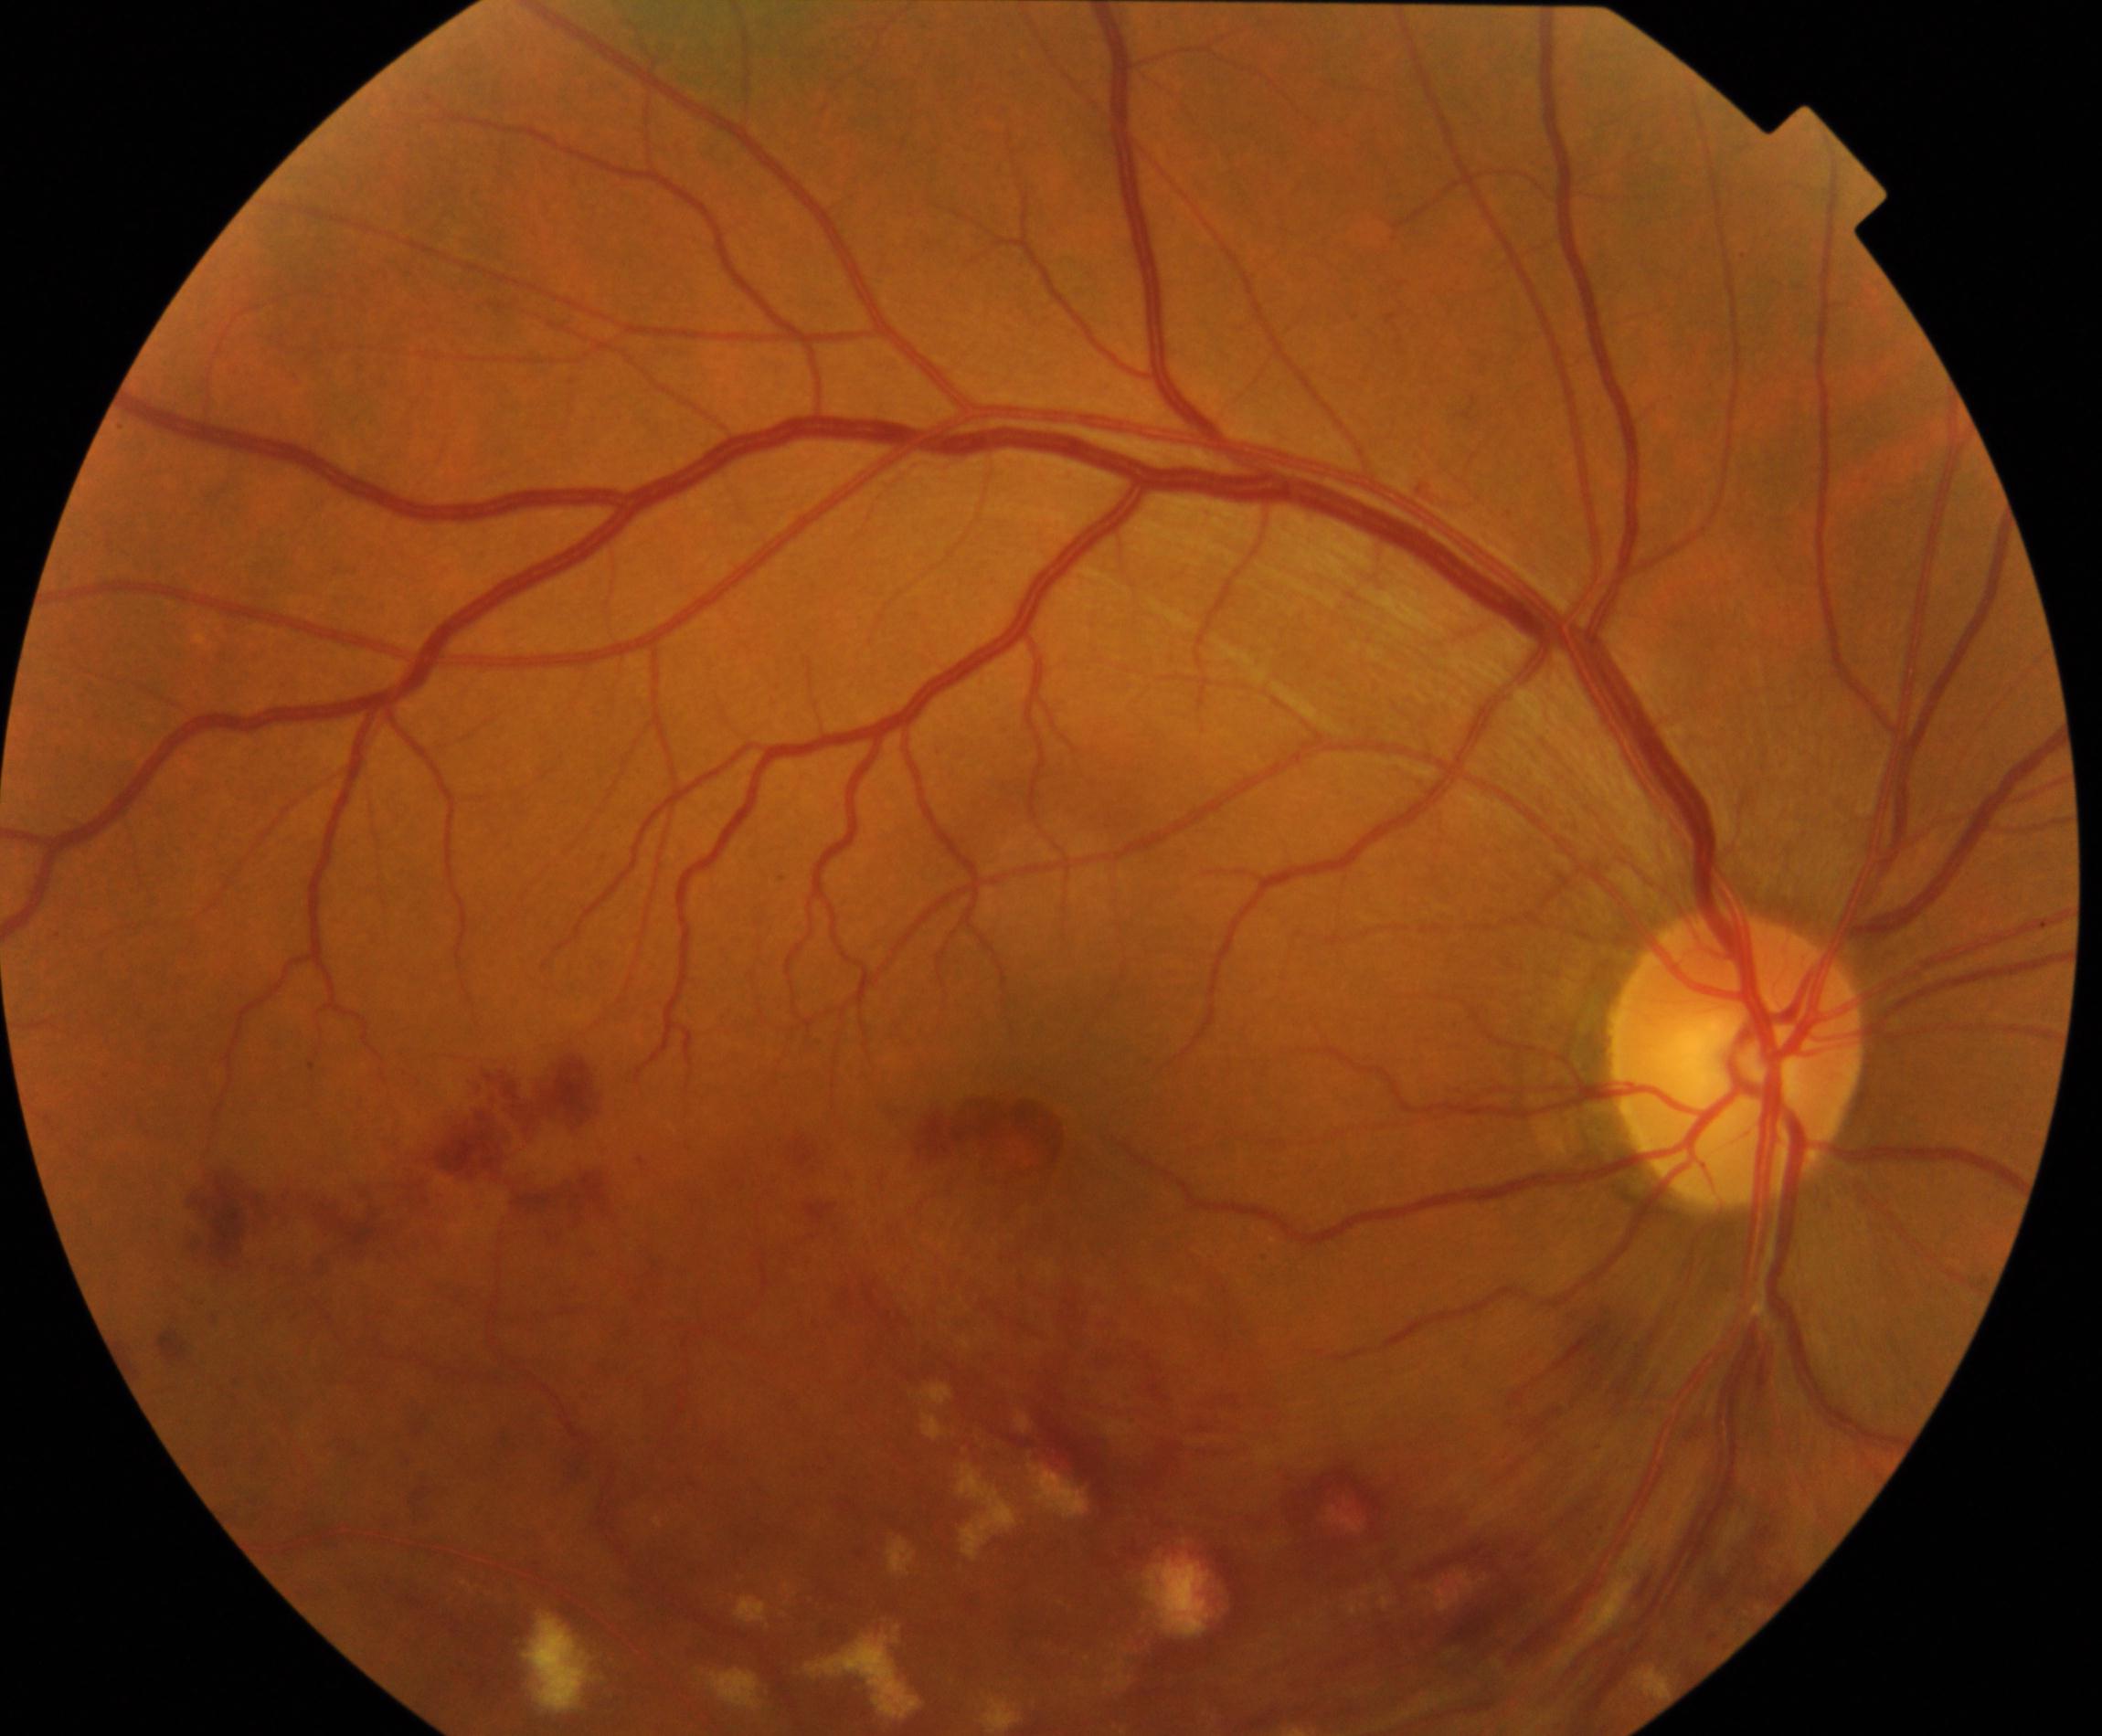 Classification: branch retinal vein occlusion.